640x480. Wide-field fundus photograph of an infant: 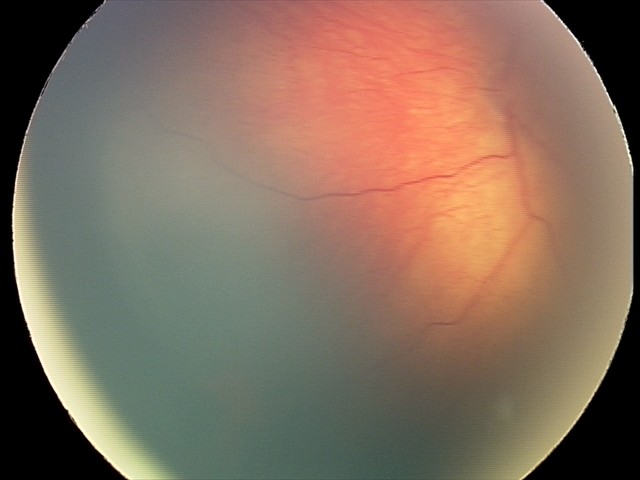 Q: What was the screening finding?
A: retinal hemorrhages